Wide-field contact fundus photograph of an infant · 100° field of view (Phoenix ICON): 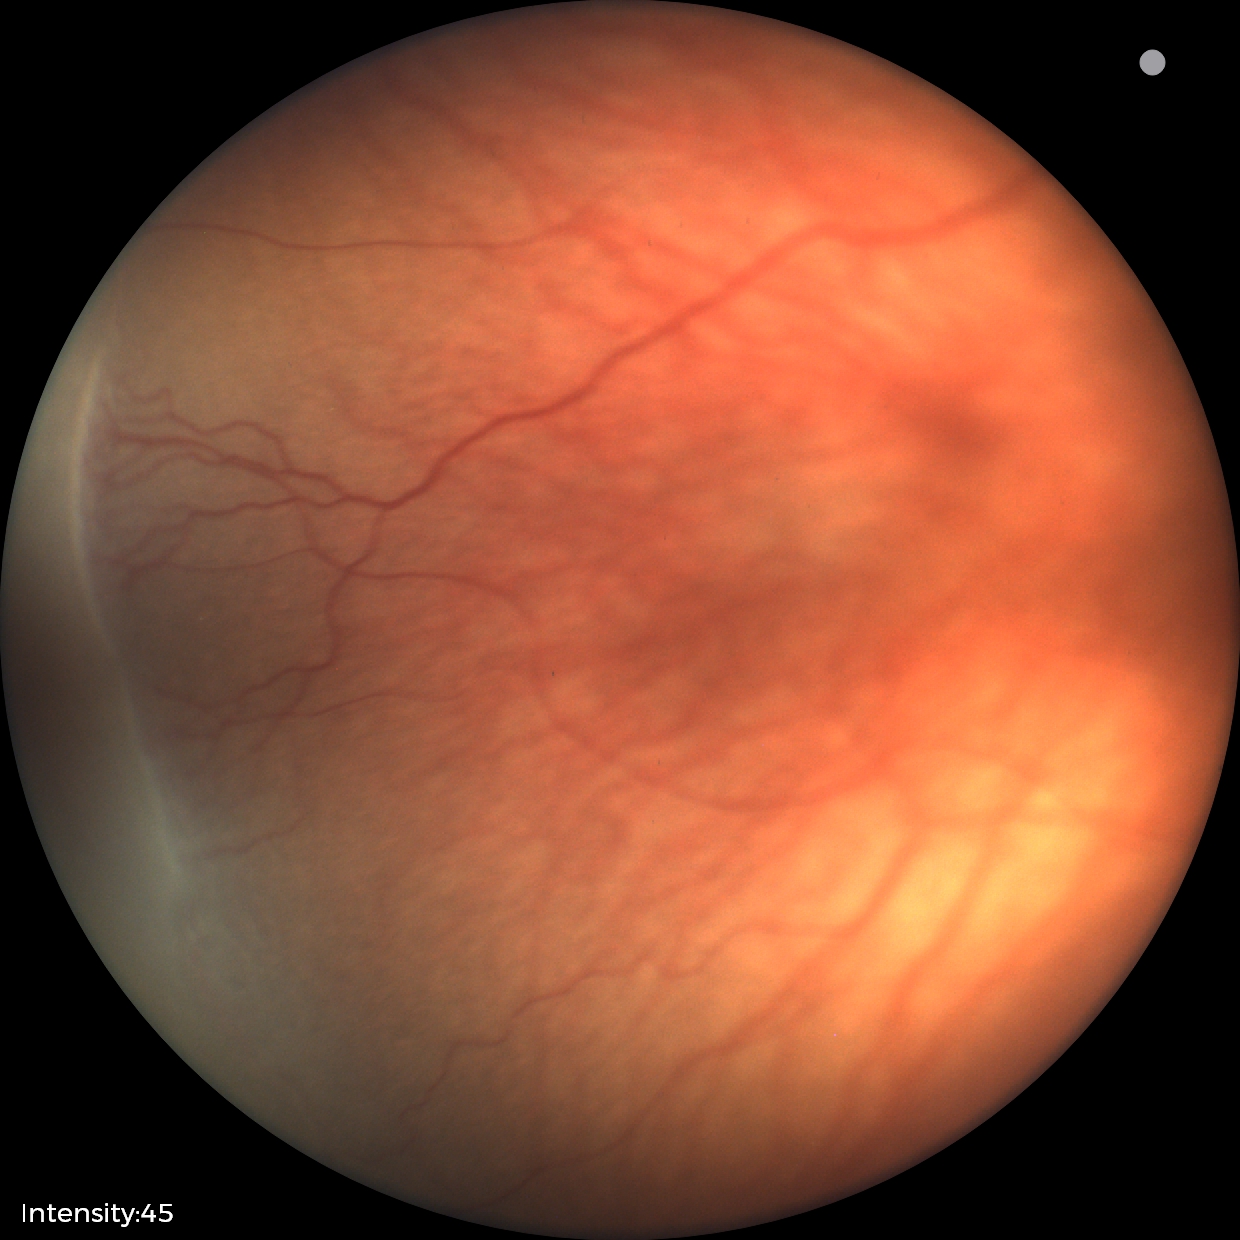

Impression = ROP stage 1